45-degree field of view; 2352 x 1568 pixels; retinal fundus photograph
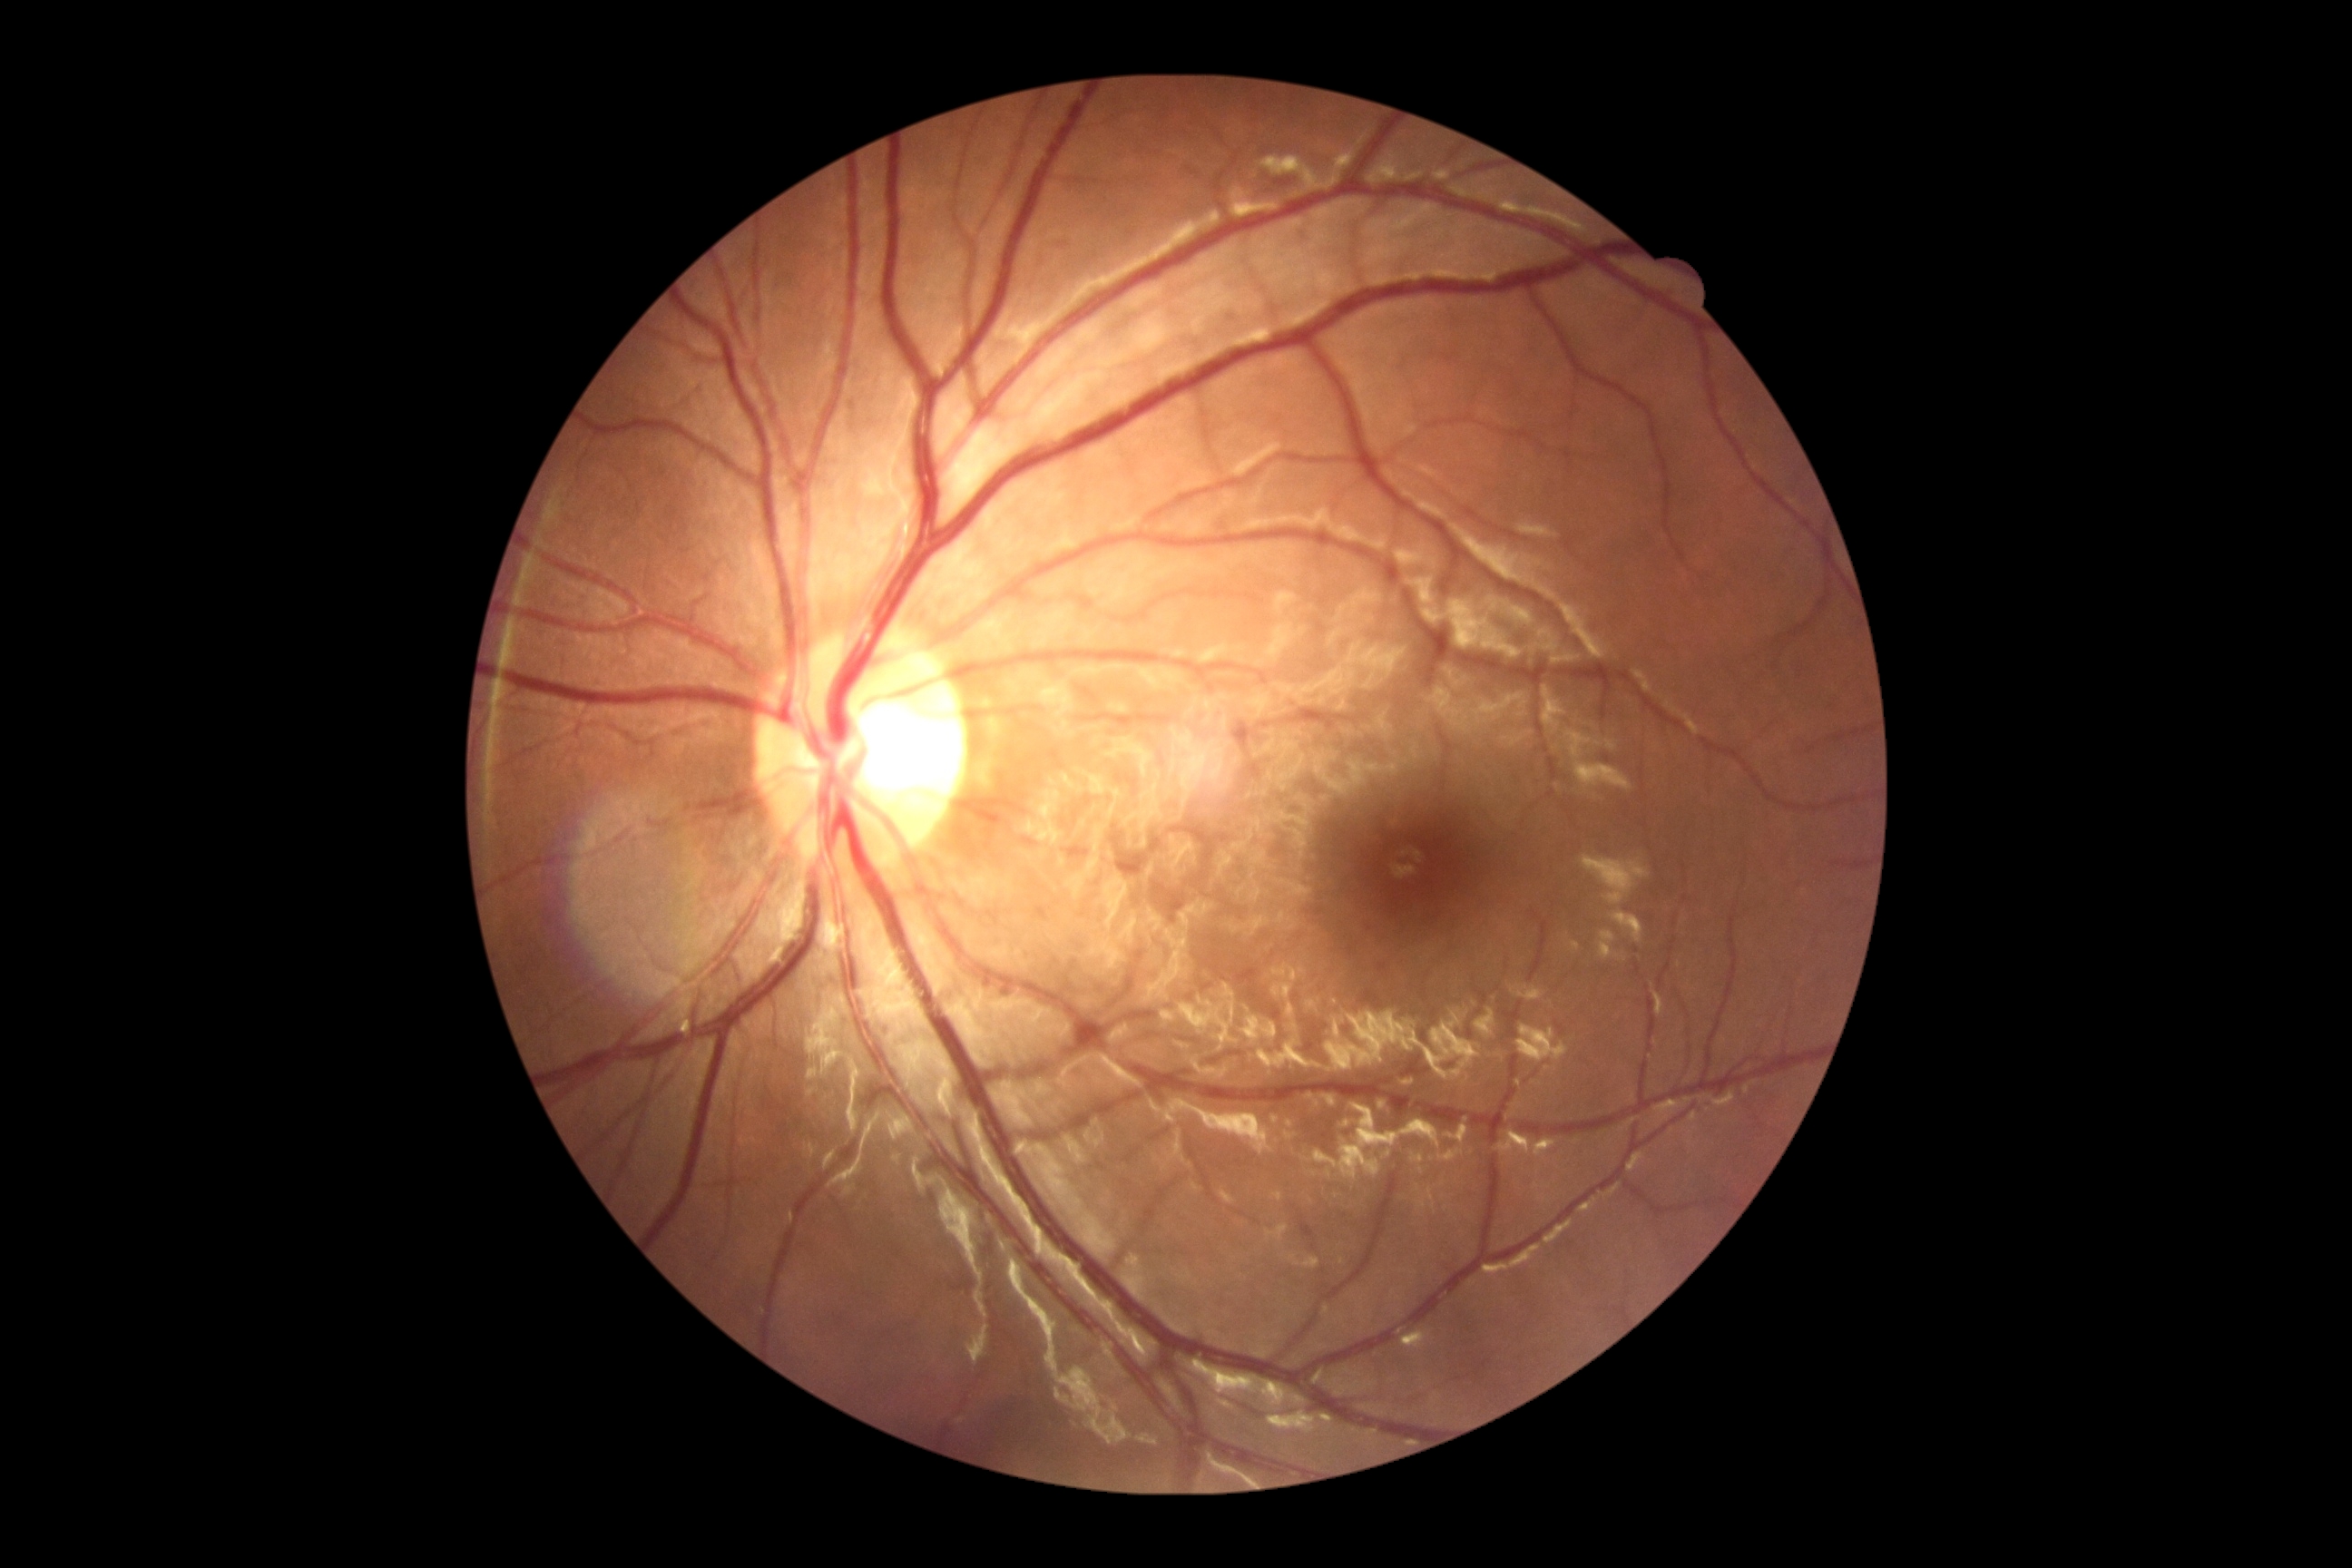

Diabetic retinopathy (DR) is grade 0.